45-degree field of view · CFP · 2048 x 1536 pixels: 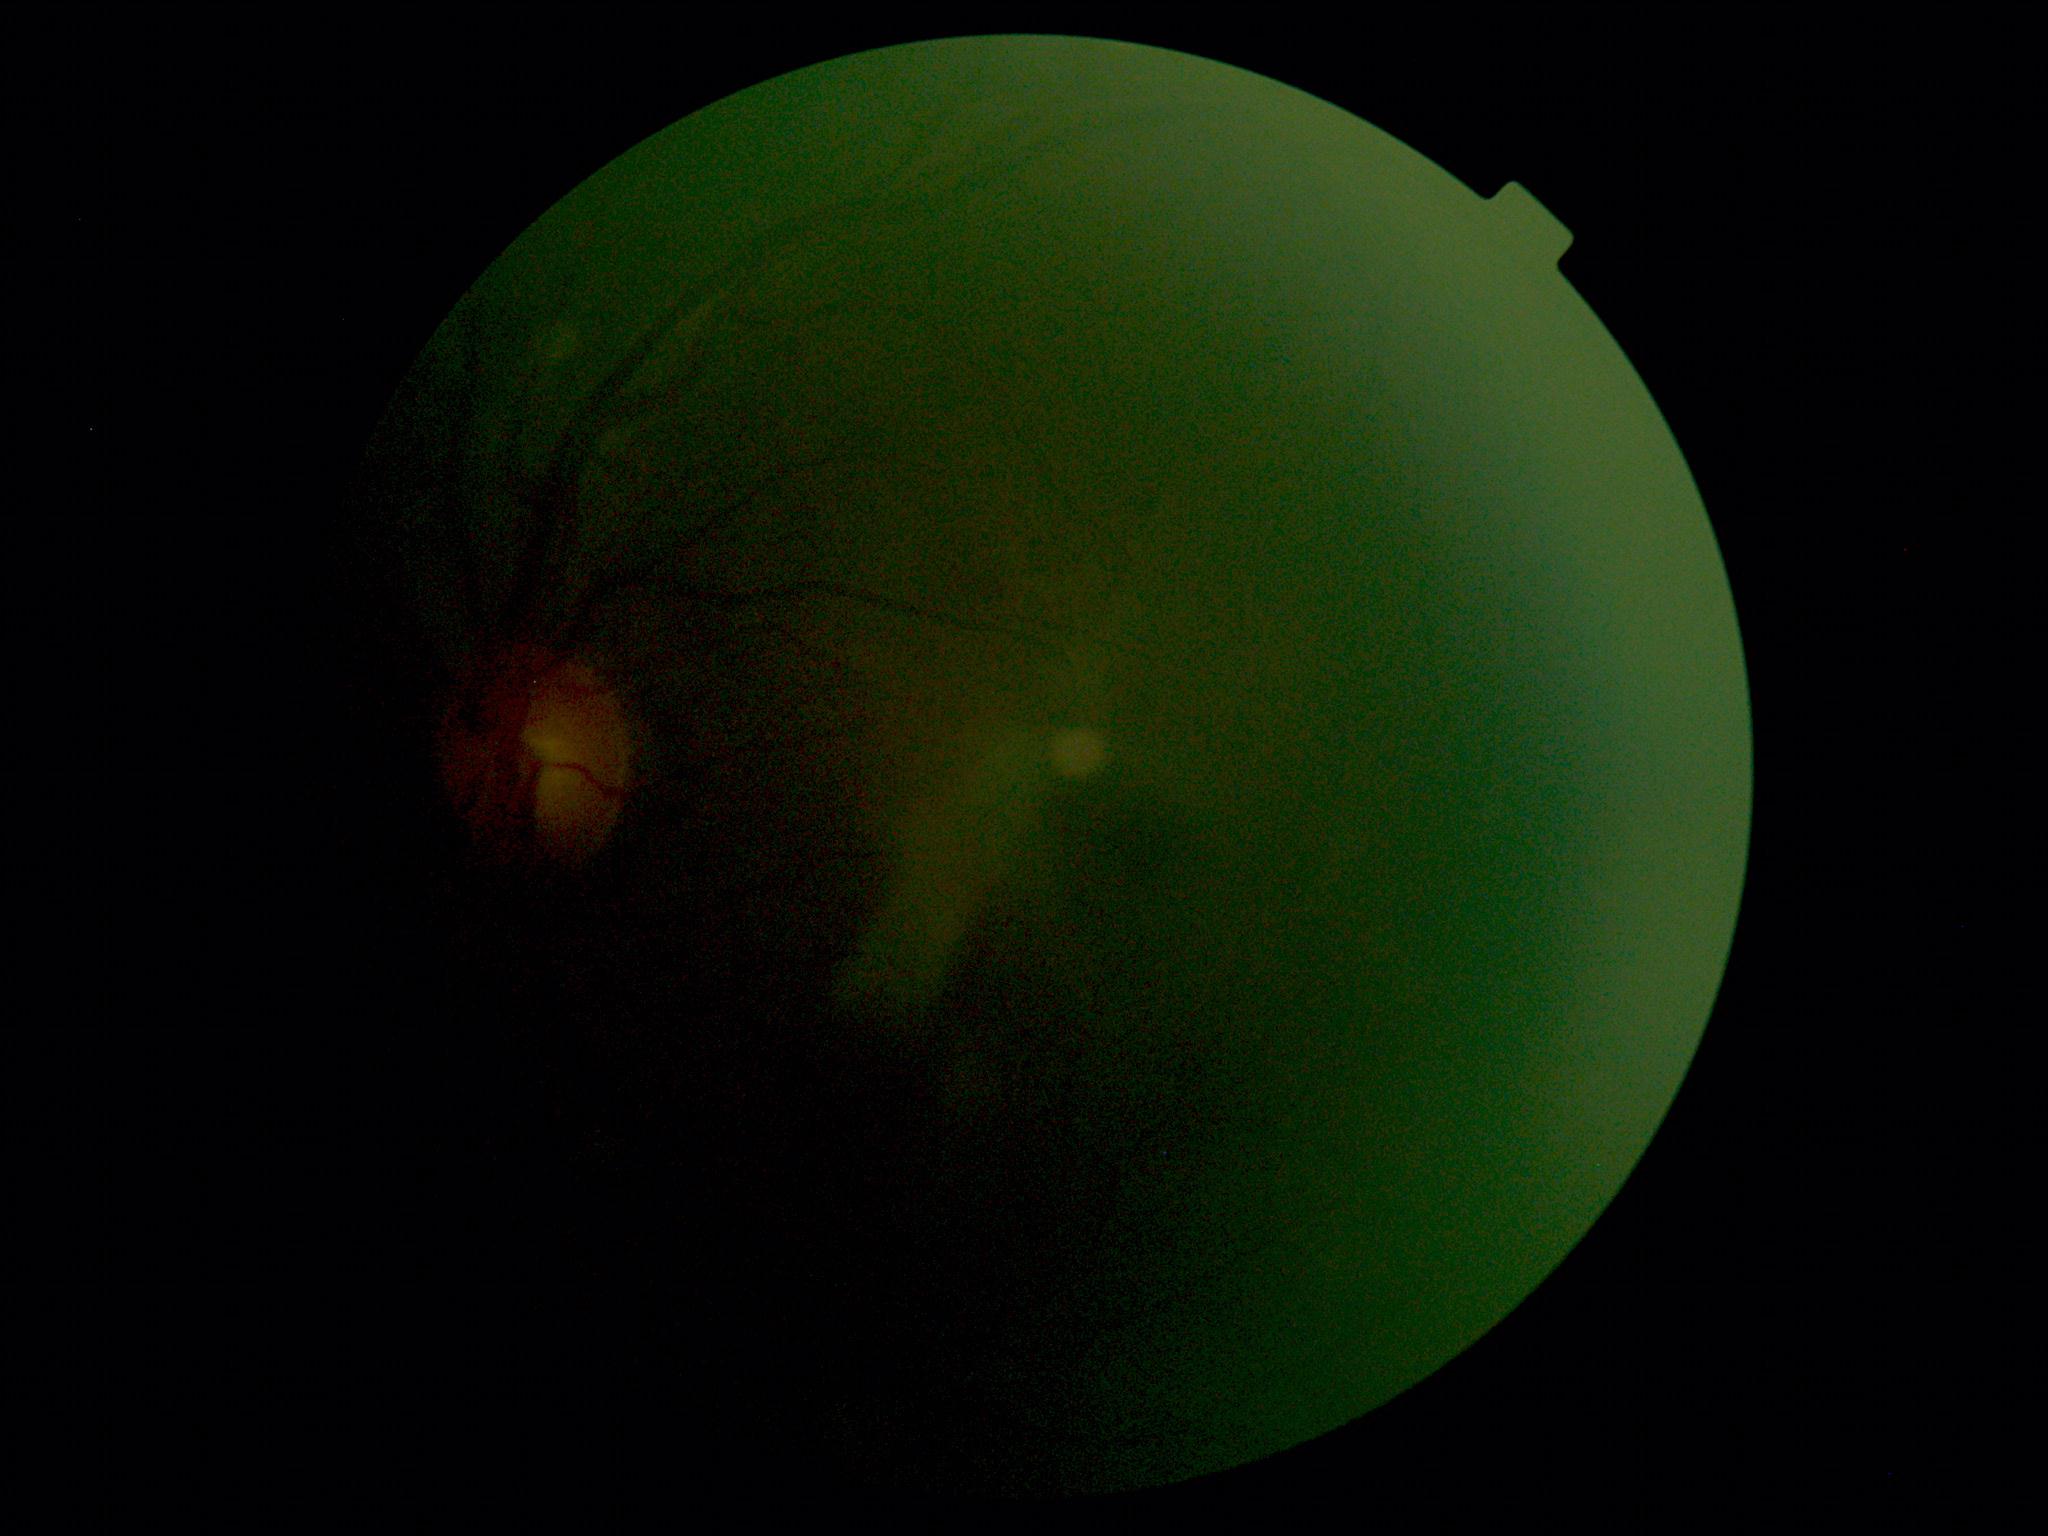
{"dr_grade": "ungradable"}